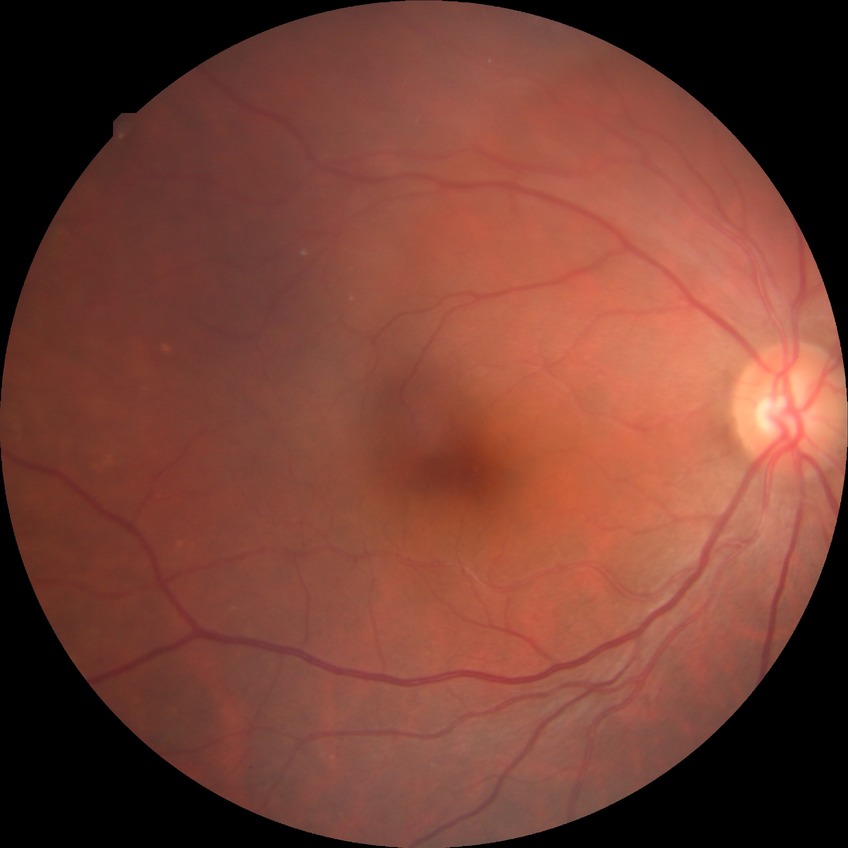 diabetic retinopathy (DR) = NDR (no diabetic retinopathy).